Infant wide-field fundus photograph · Clarity RetCam 3, 130° FOV.
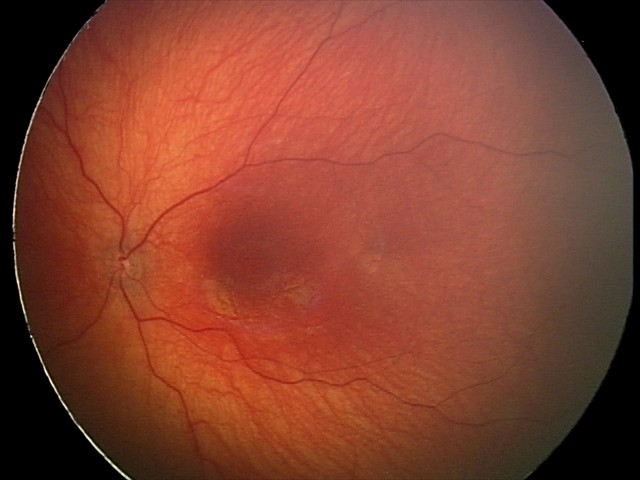
Screening examination consistent with optic nerve hypoplasia.